Infant wide-field retinal image. 1440 by 1080 pixels. Natus RetCam Envision, 130° FOV
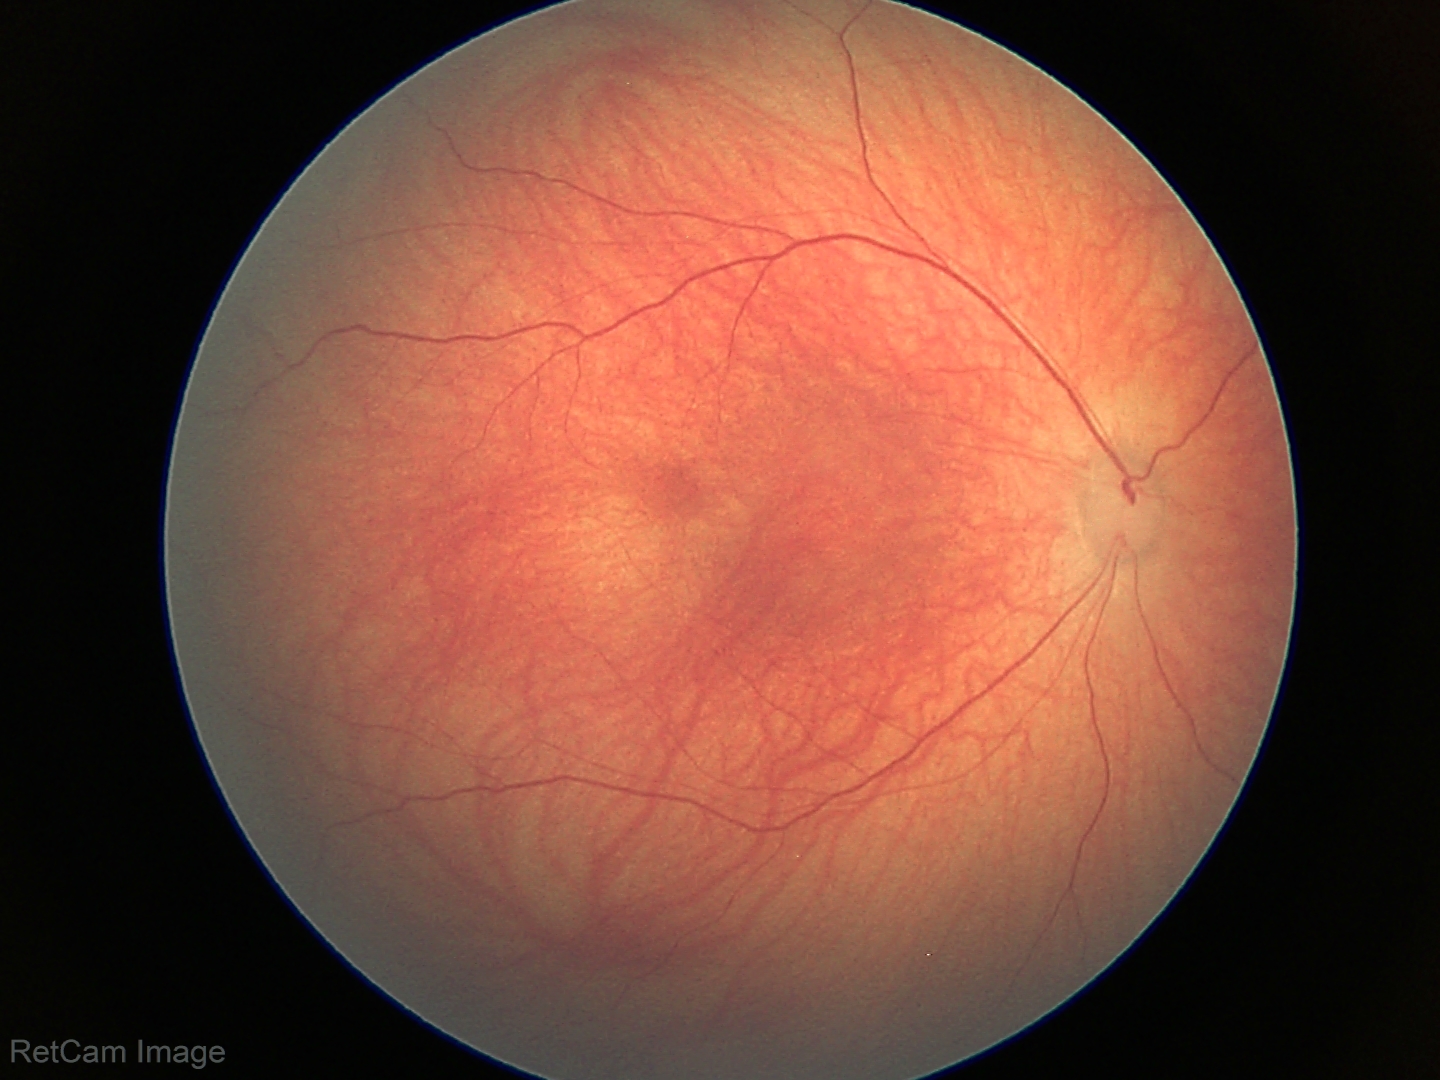

Diagnosis: physiological appearance.